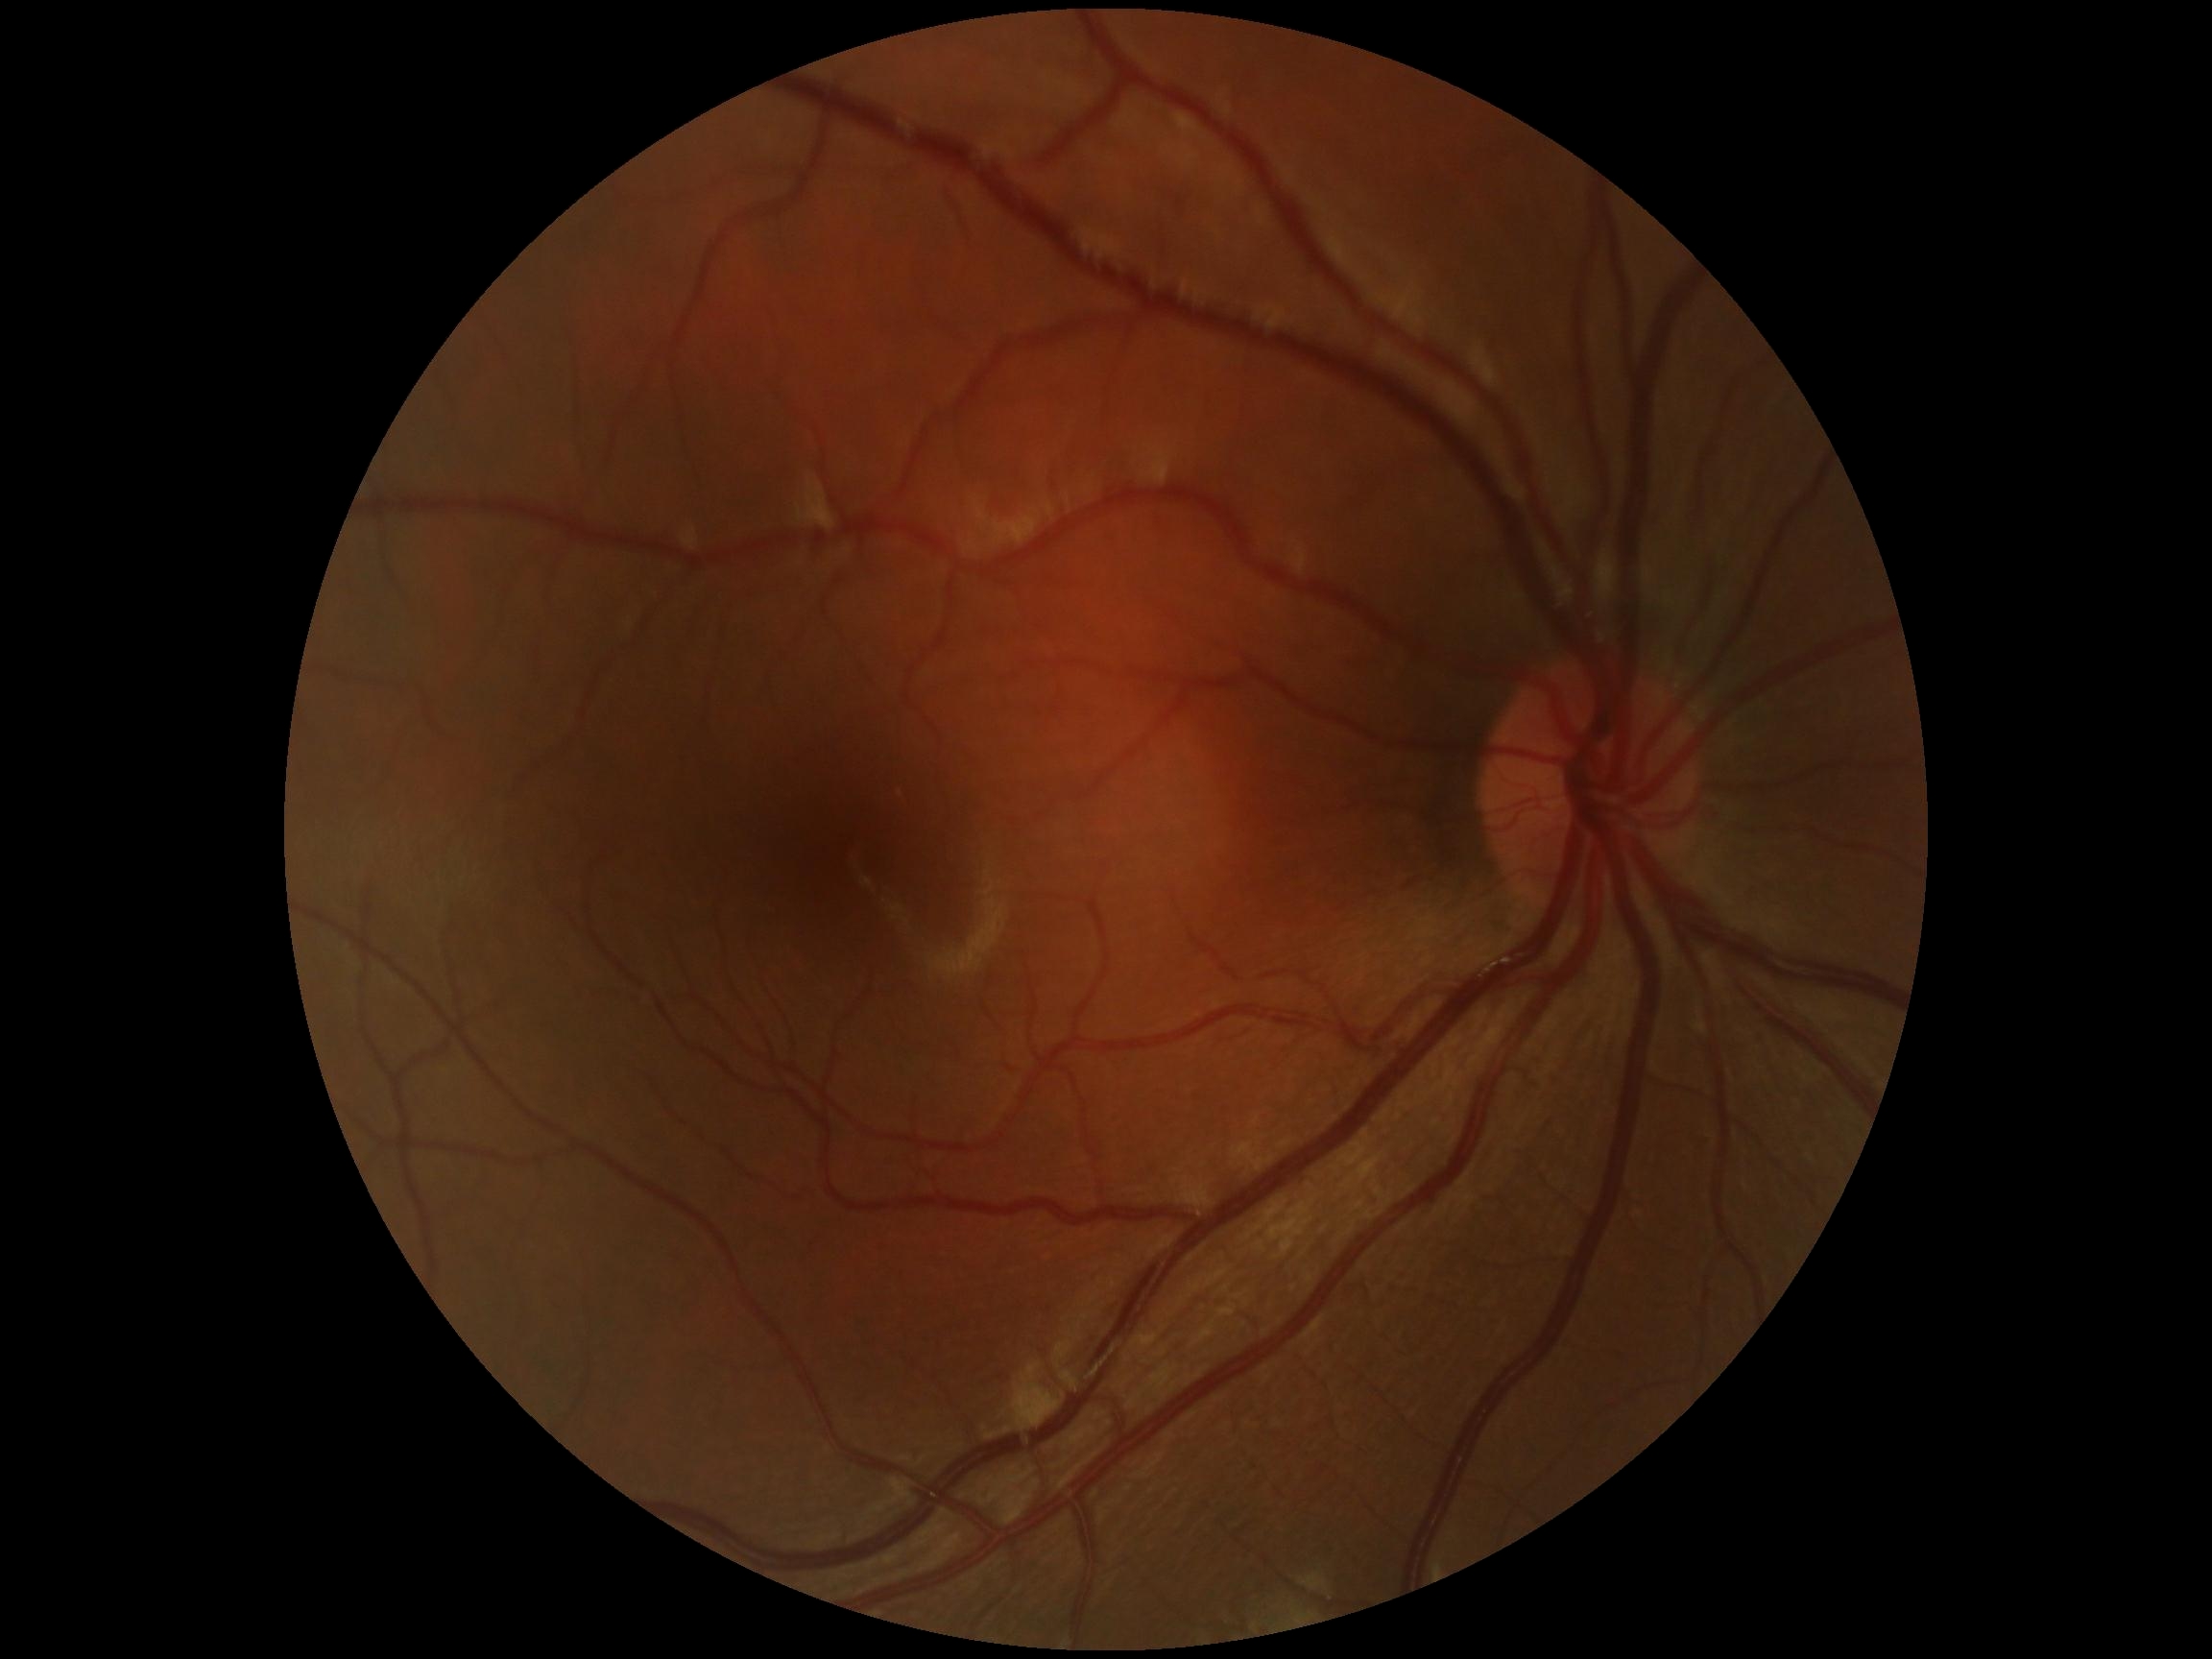 {
  "dr_grade": "0 (no apparent retinopathy)"
}